FOV: 45 degrees · 2352 by 1568 pixels
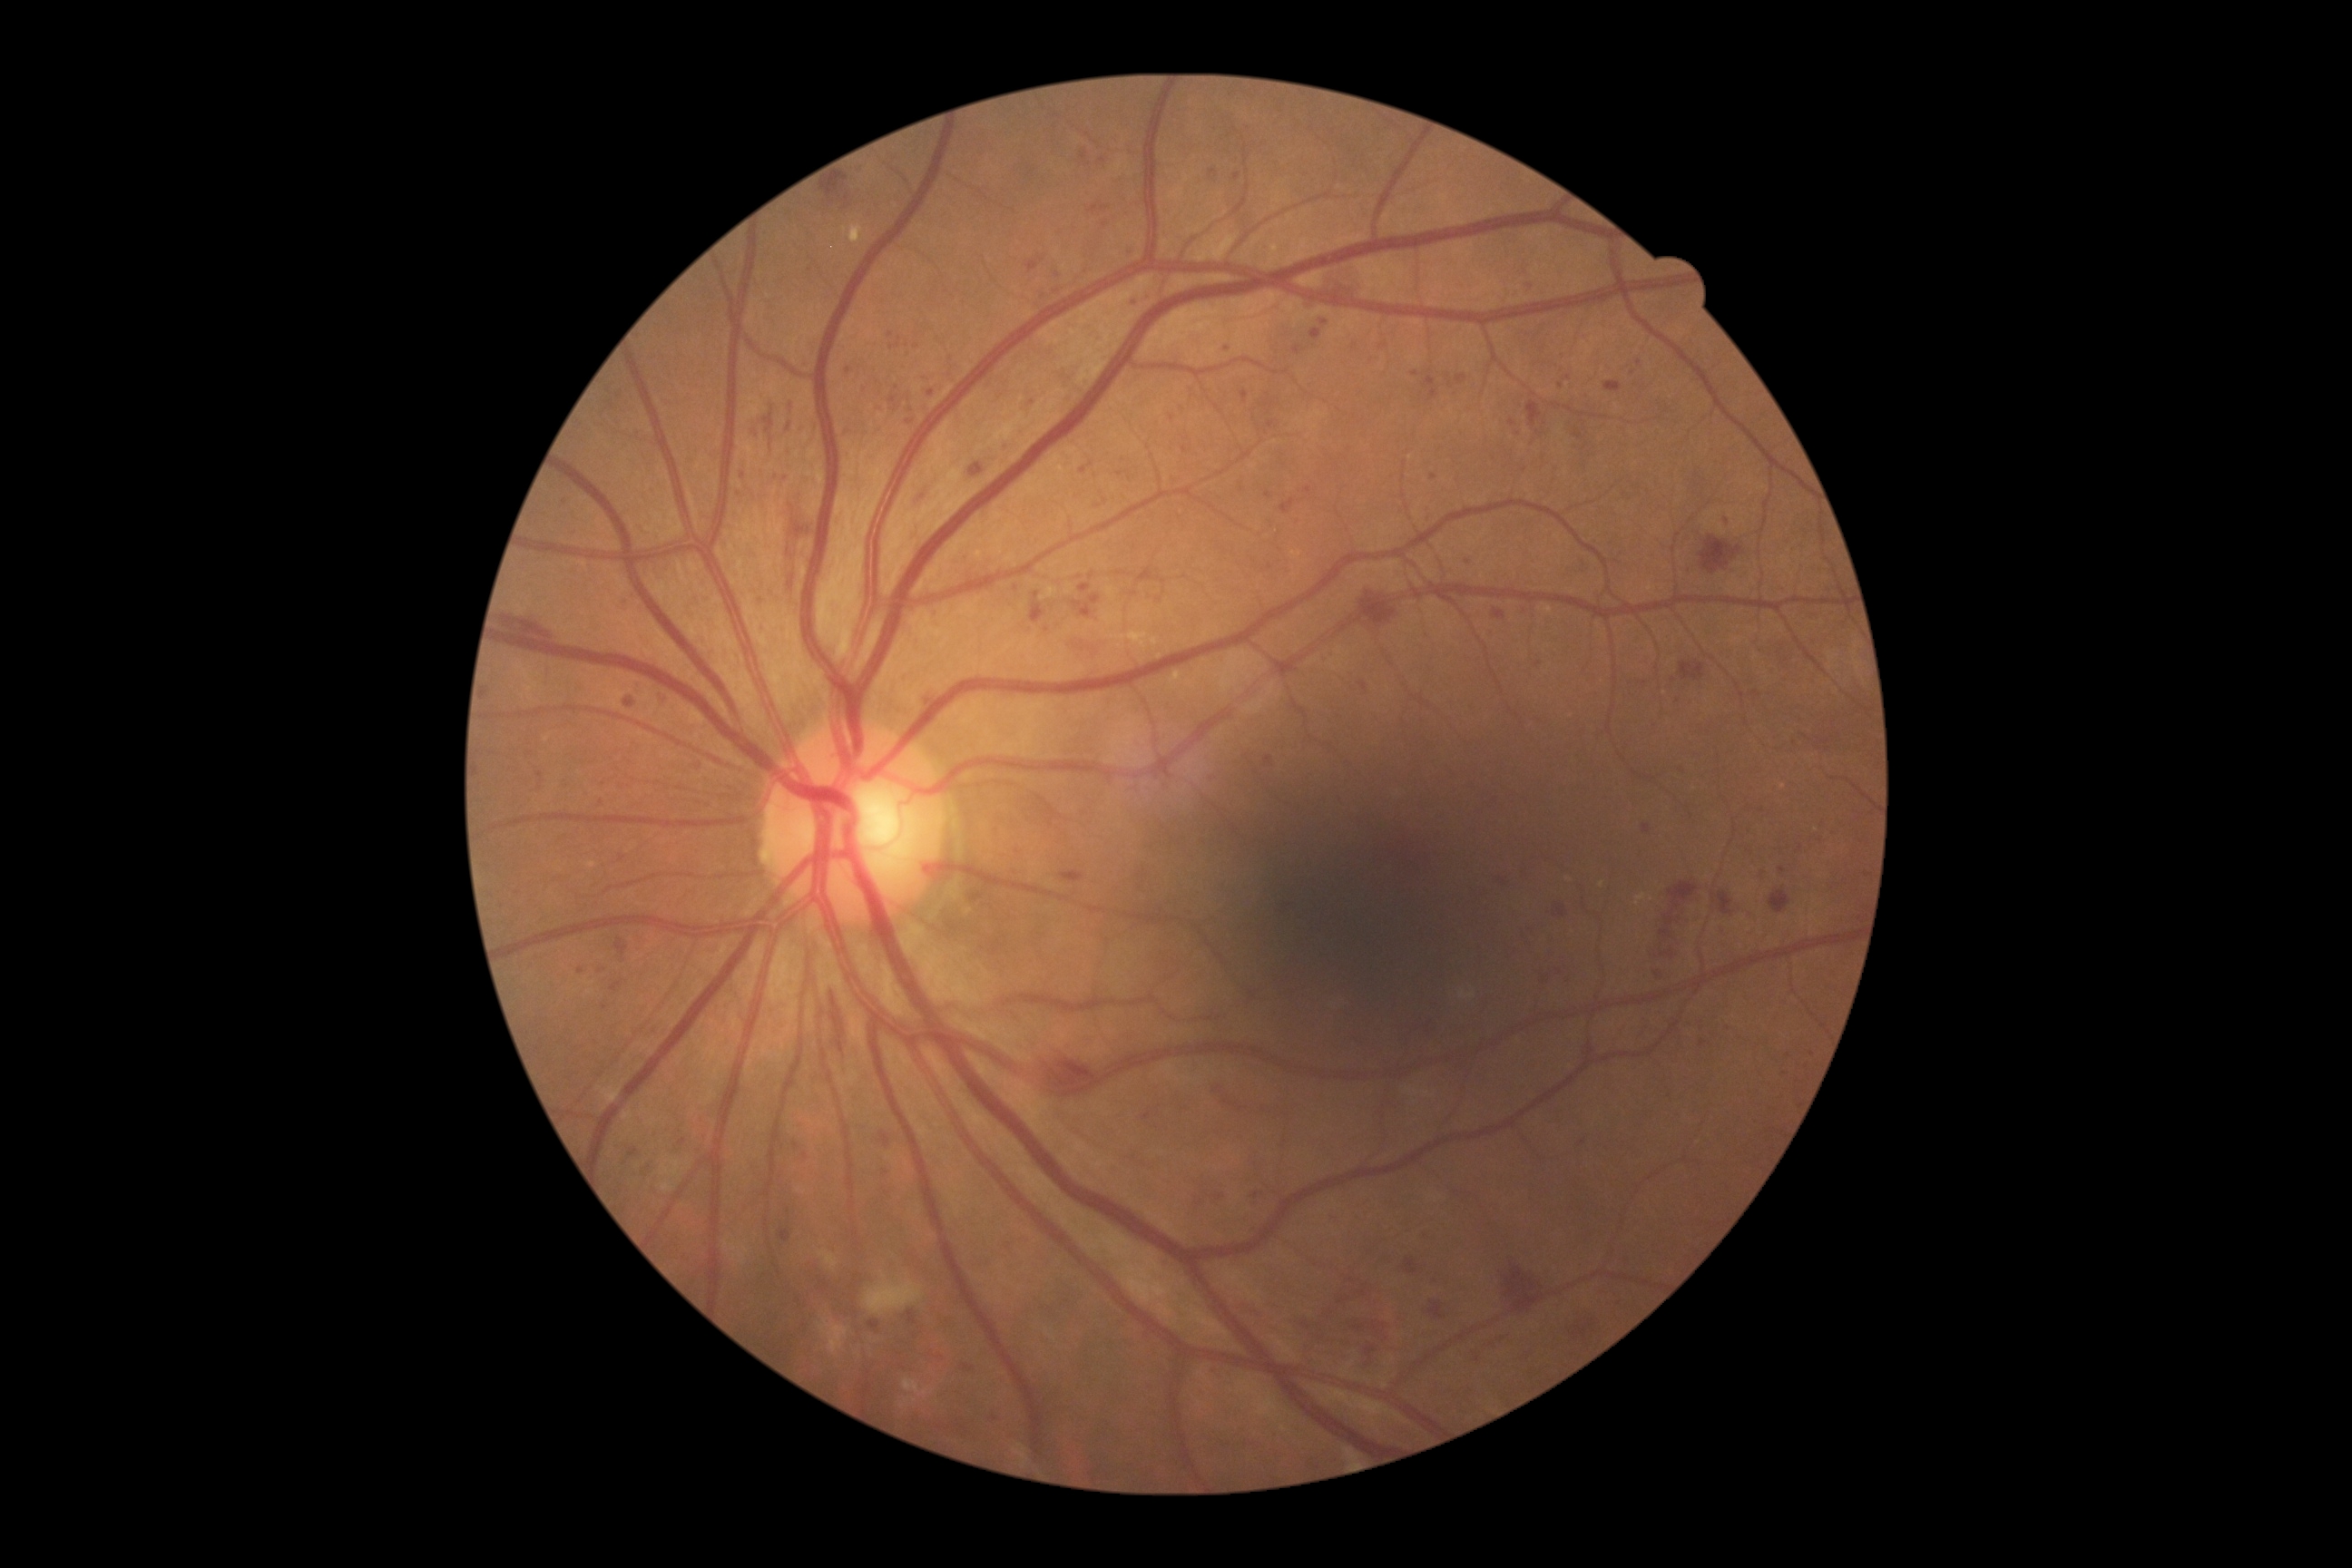 DR severity: grade 3
A subset of detected lesions:
MAs (subset): l=1128, t=244, r=1133, b=253; l=1130, t=299, r=1141, b=306; l=1306, t=295, r=1315, b=302; l=1456, t=375, r=1467, b=386; l=1680, t=696, r=1683, b=705; l=765, t=415, r=774, b=435; l=1518, t=609, r=1527, b=620; l=658, t=694, r=667, b=709
Smaller MAs around x=788 y=1211; x=605 y=1007; x=1561 y=385; x=1430 y=510; x=1563 y=359; x=1325 y=324; x=893 y=400; x=1105 y=225; x=1213 y=173; x=1307 y=490